Captured after pupil dilation: 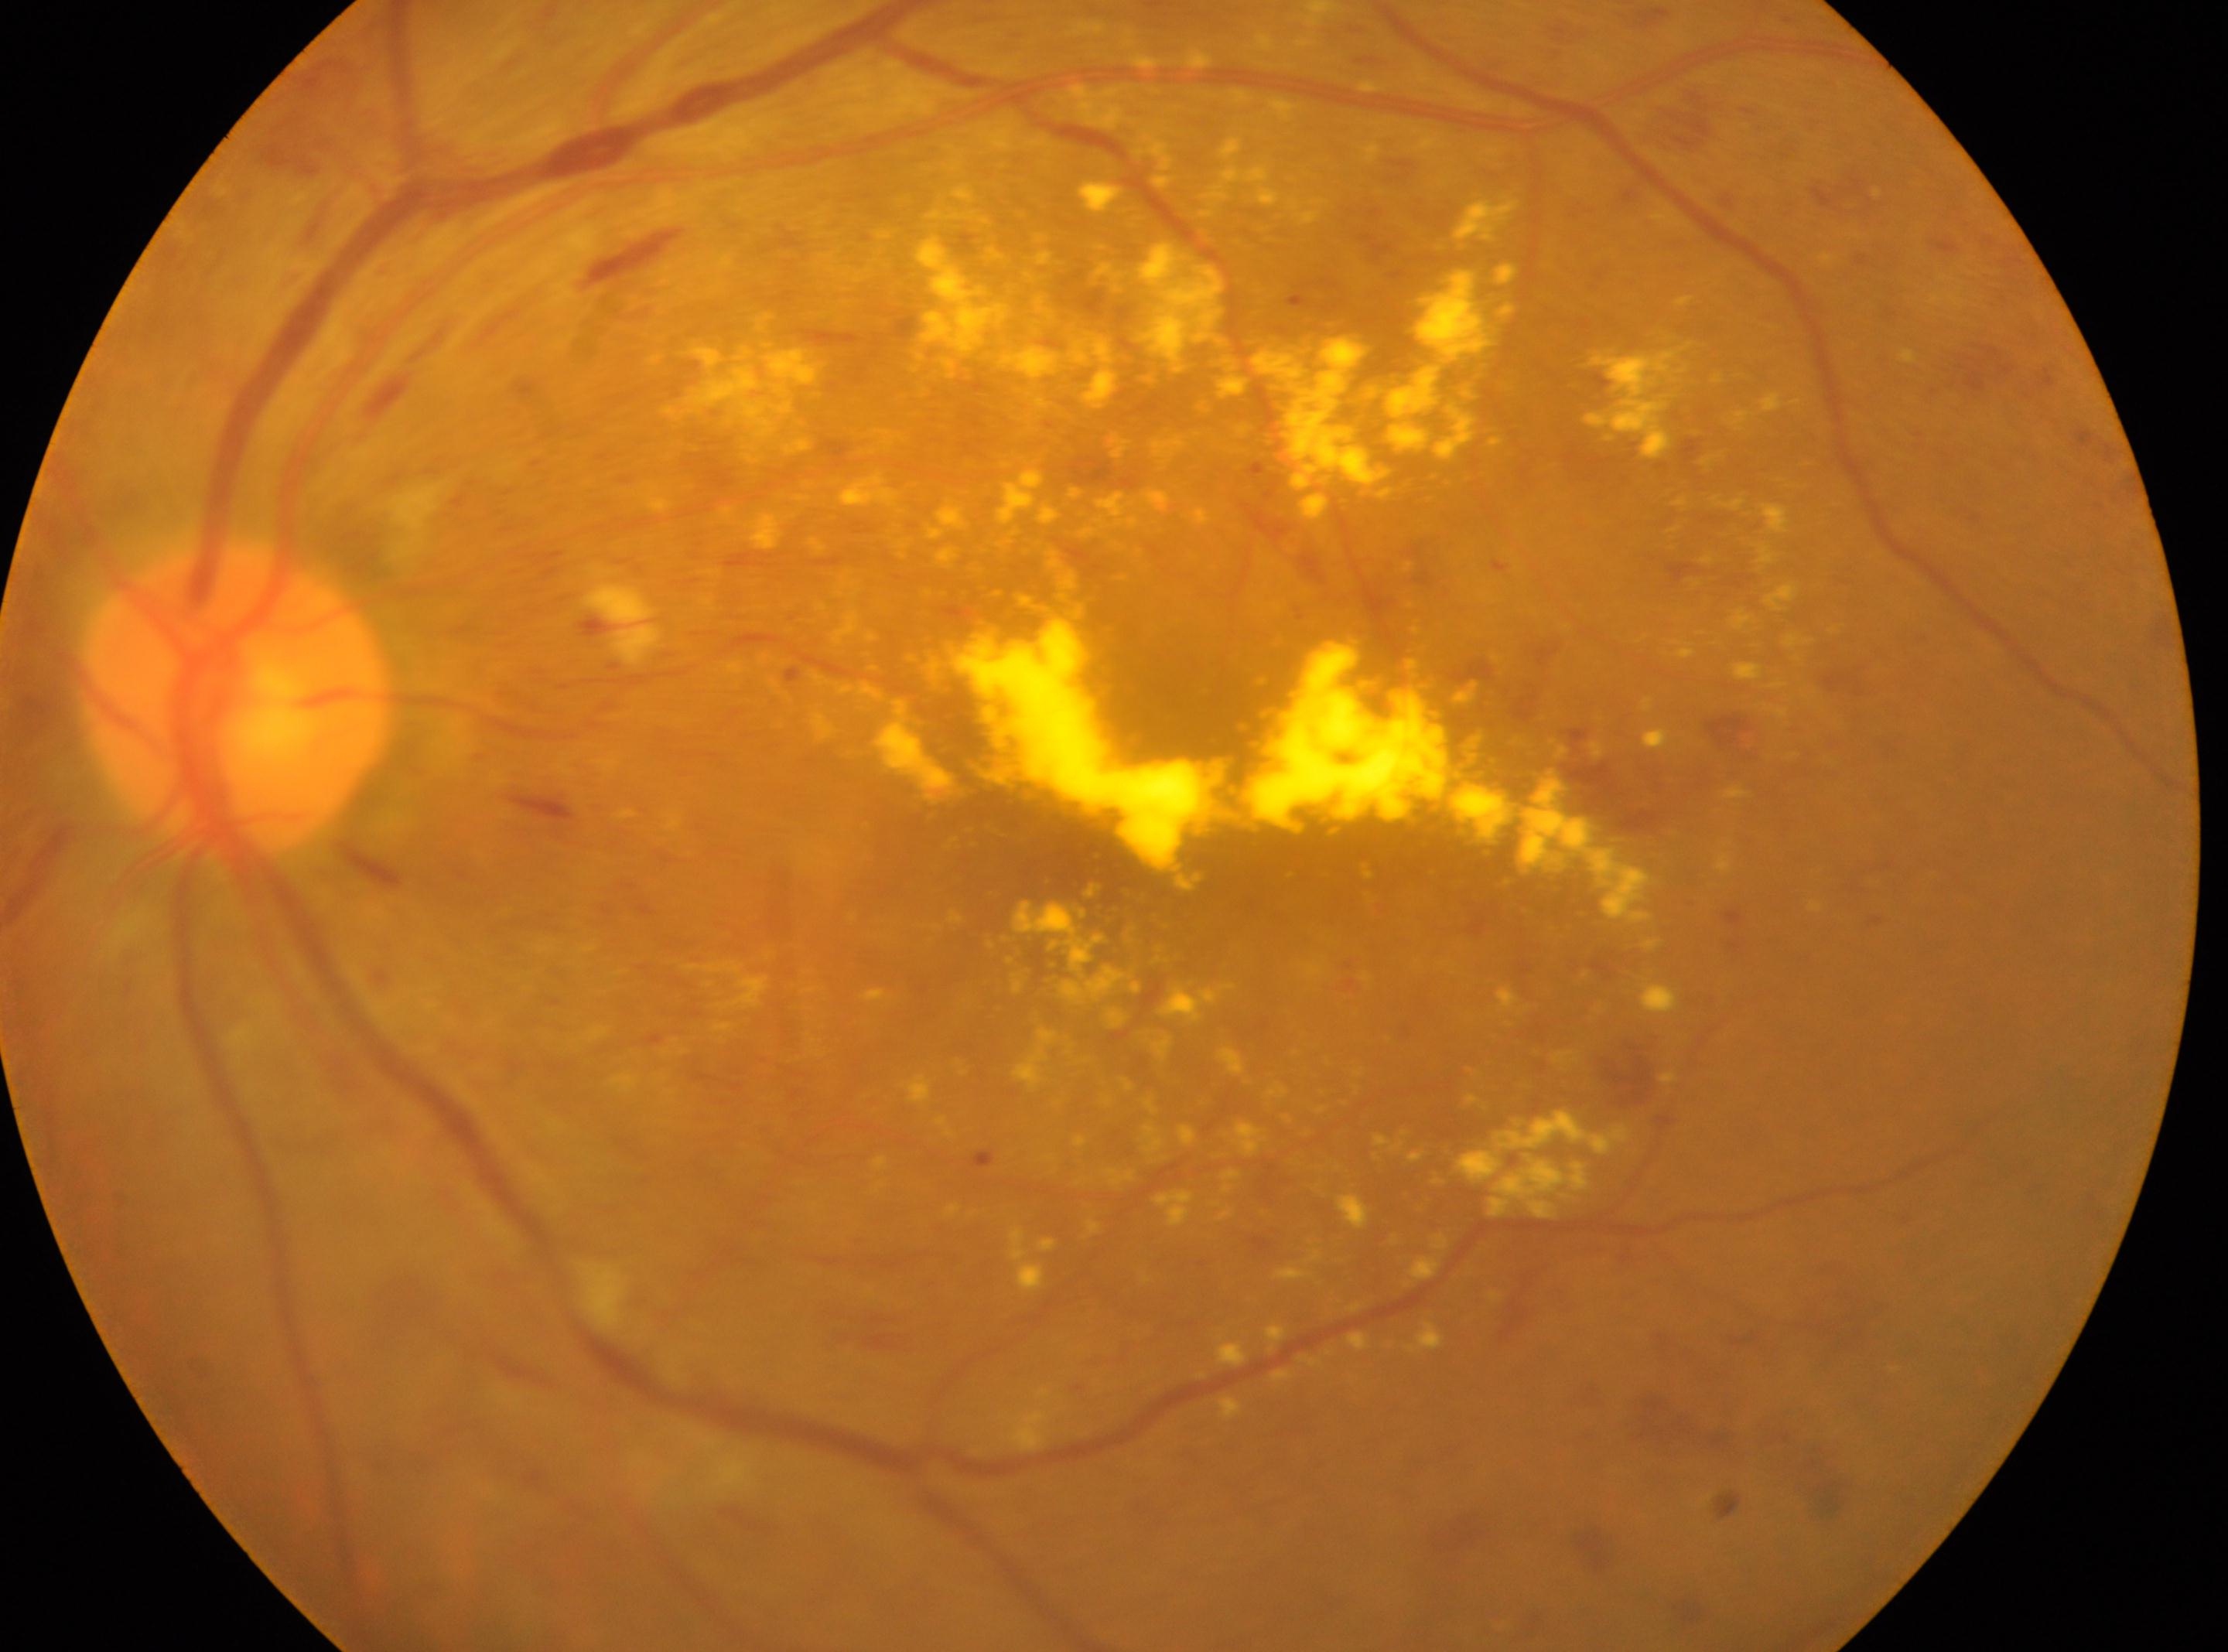
Disease class: non-proliferative diabetic retinopathy. Disc center: [235, 705]. Macular center located at [1037, 855]. Diabetic retinopathy (DR): severe non-proliferative diabetic retinopathy (grade 3). This is the left eye.